2212x1659px
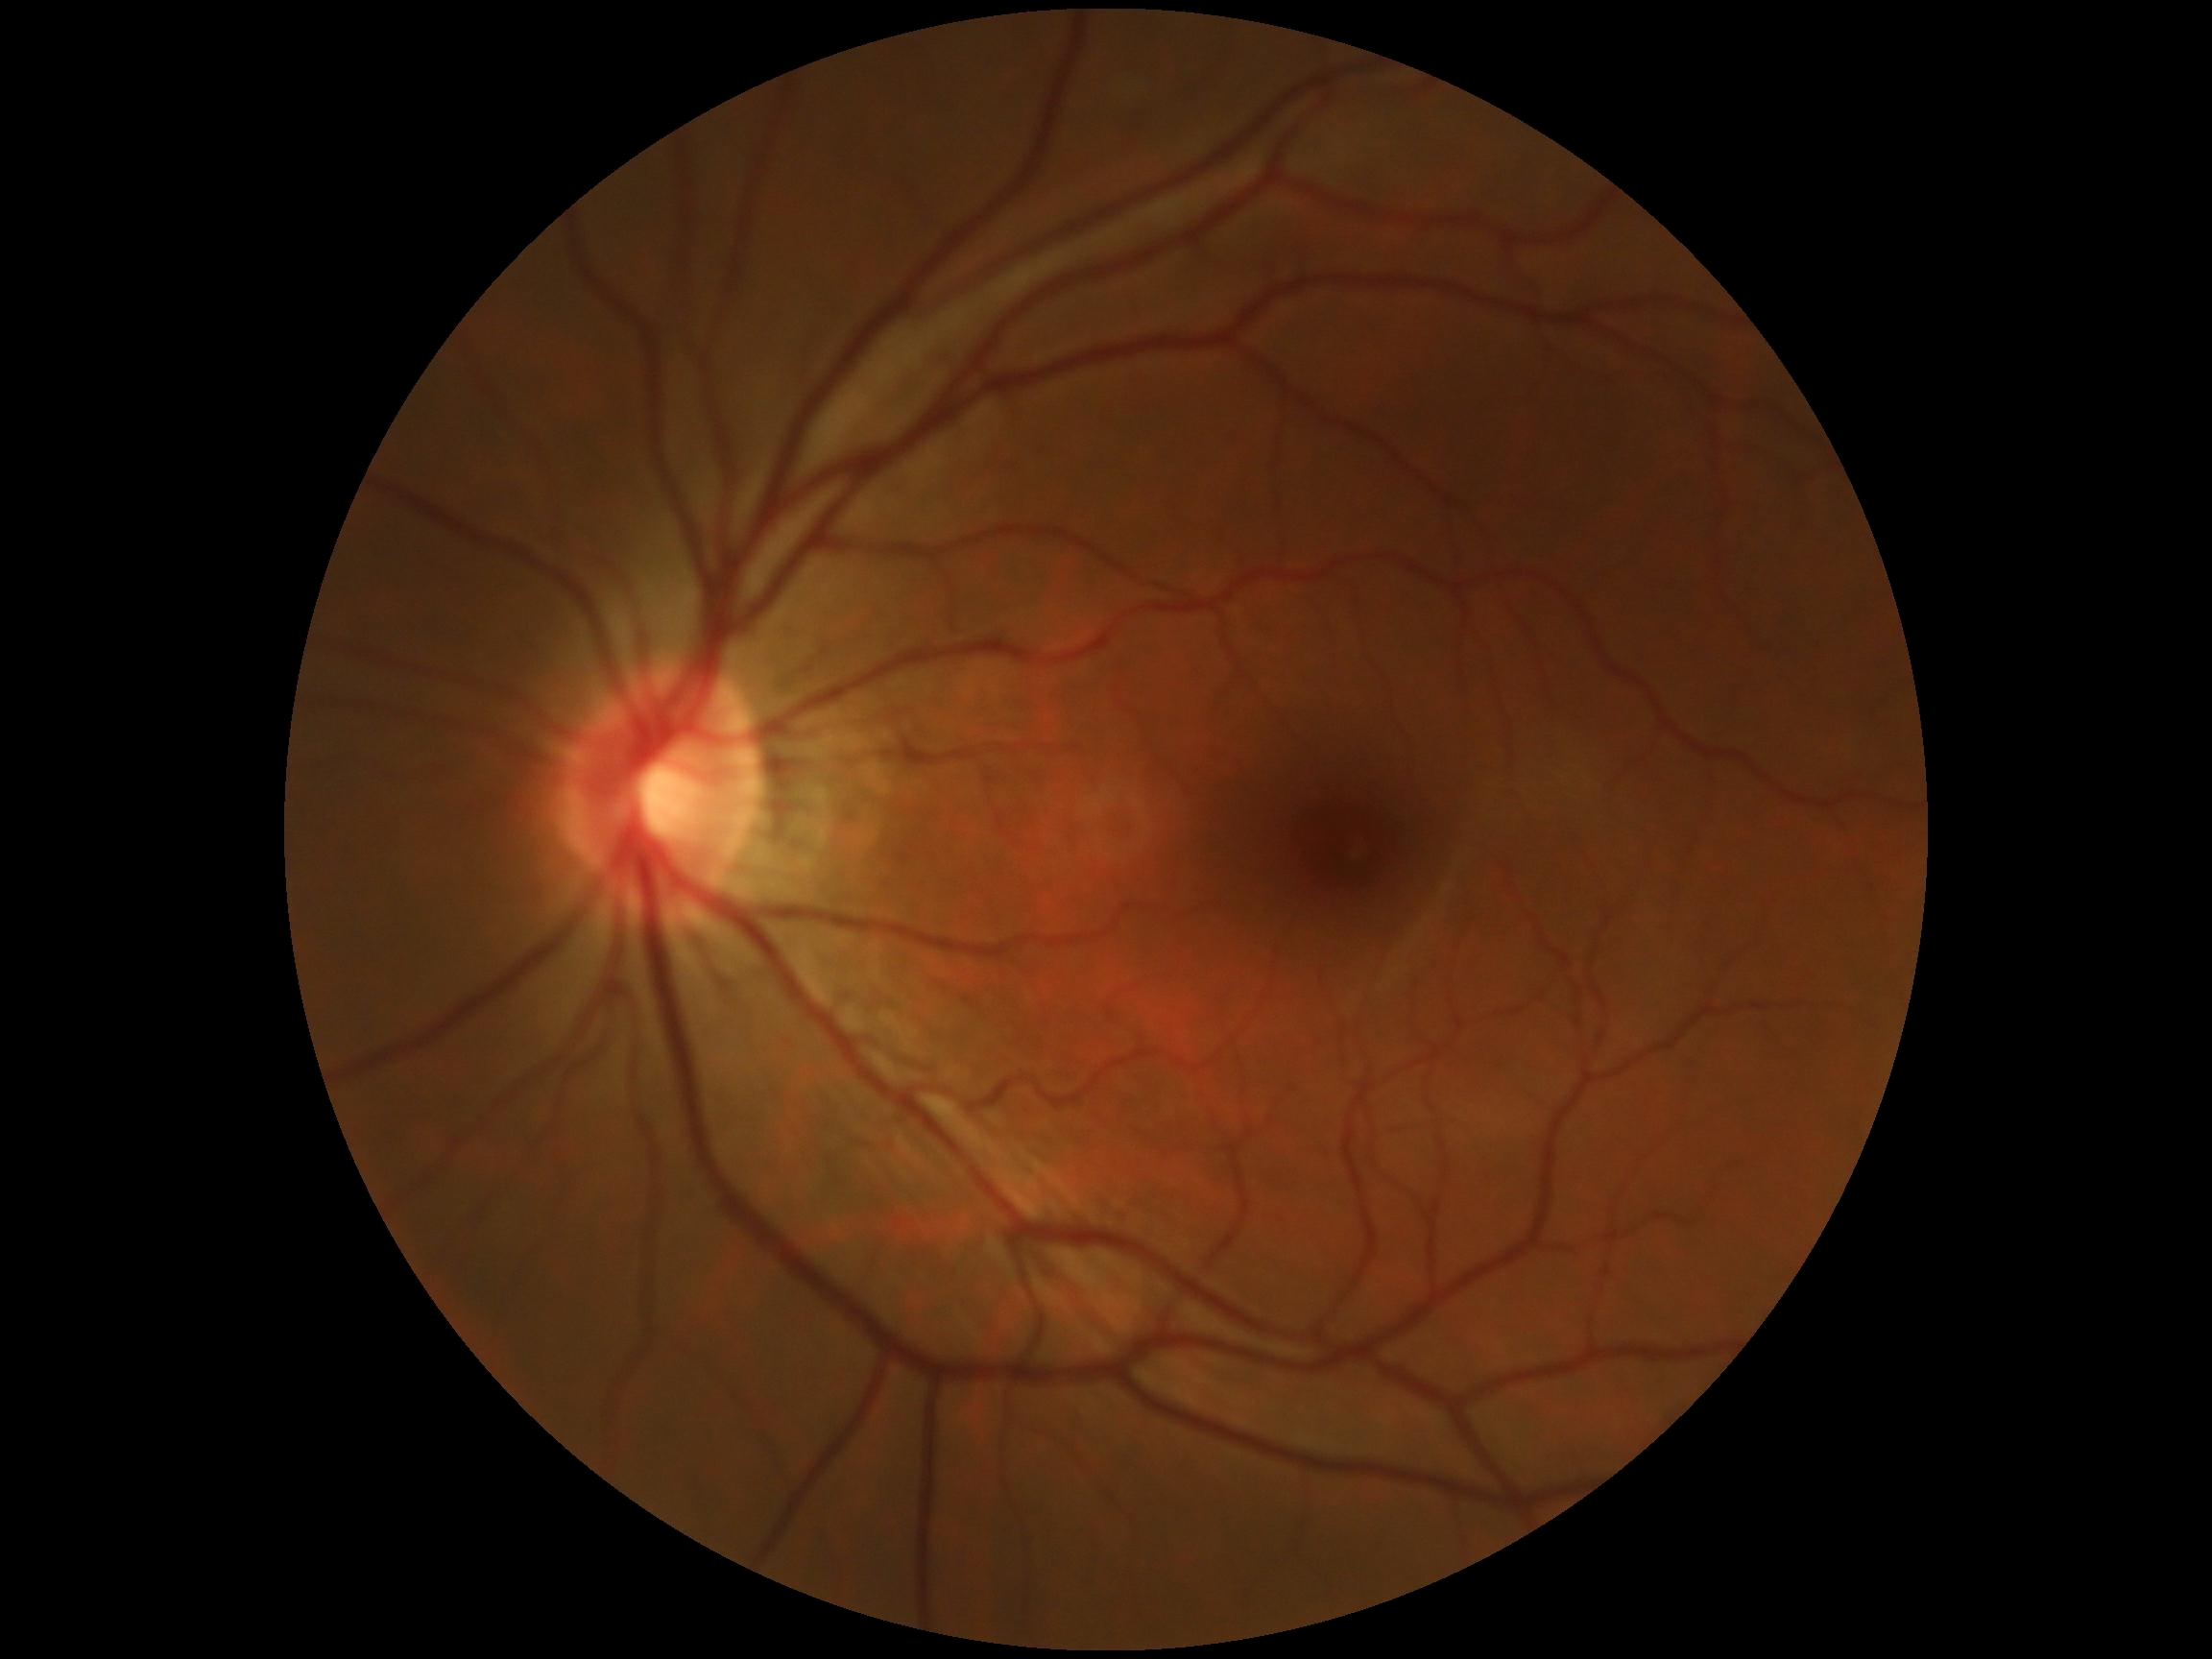

Diabetic retinopathy: grade 0 (no apparent retinopathy) — no visible signs of diabetic retinopathy.